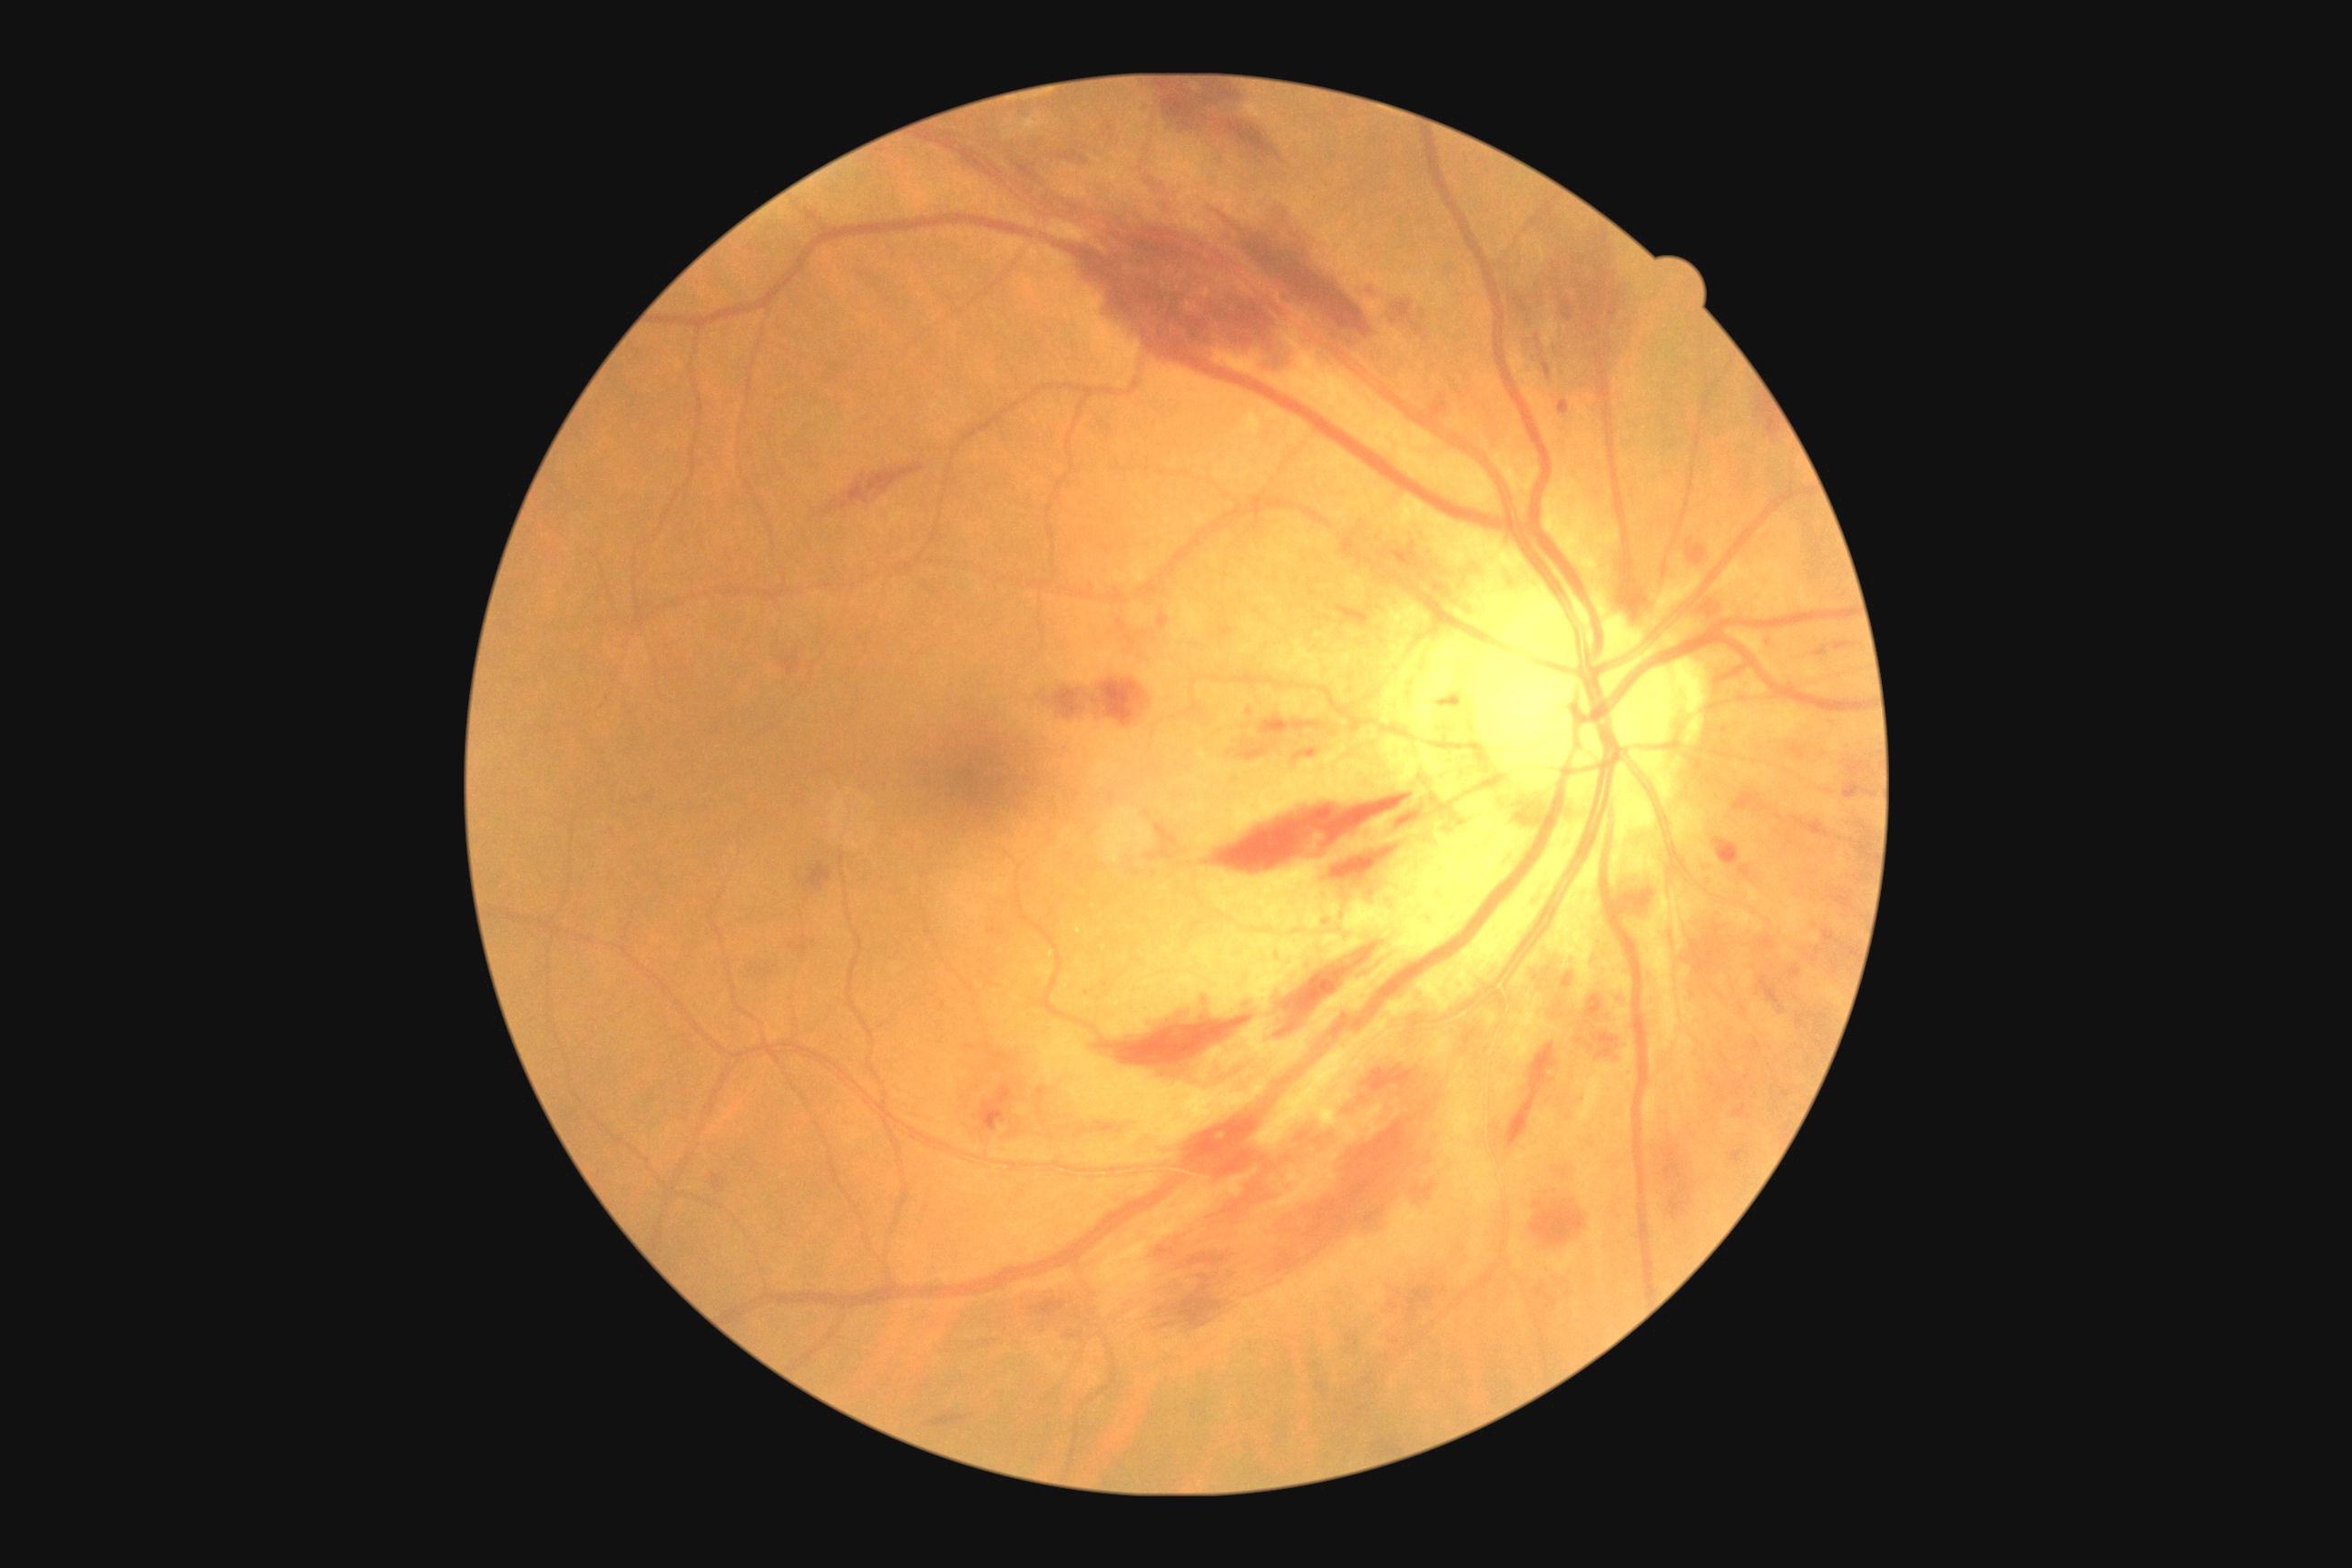

Diabetic retinopathy (DR) is grade 2 (moderate NPDR)
Selected lesions:
hemorrhages (HEs) (partial): (805,865,832,892) | (1823,930,1841,945) | (1563,974,1574,990) | (1696,591,1732,618) | (1663,1148,1685,1186) | (1741,789,1765,812) | (1856,839,1872,859) | (1792,745,1807,761) | (1208,792,1416,876) | (1335,865,1406,903) | (1144,88,1282,162) | (1616,994,1623,1004) | (1462,1028,1480,1052) | (1732,1106,1747,1117) | (1527,331,1554,387) | (985,1043,1010,1063)
Small HEs approximately at (1326; 923)